45° field of view — 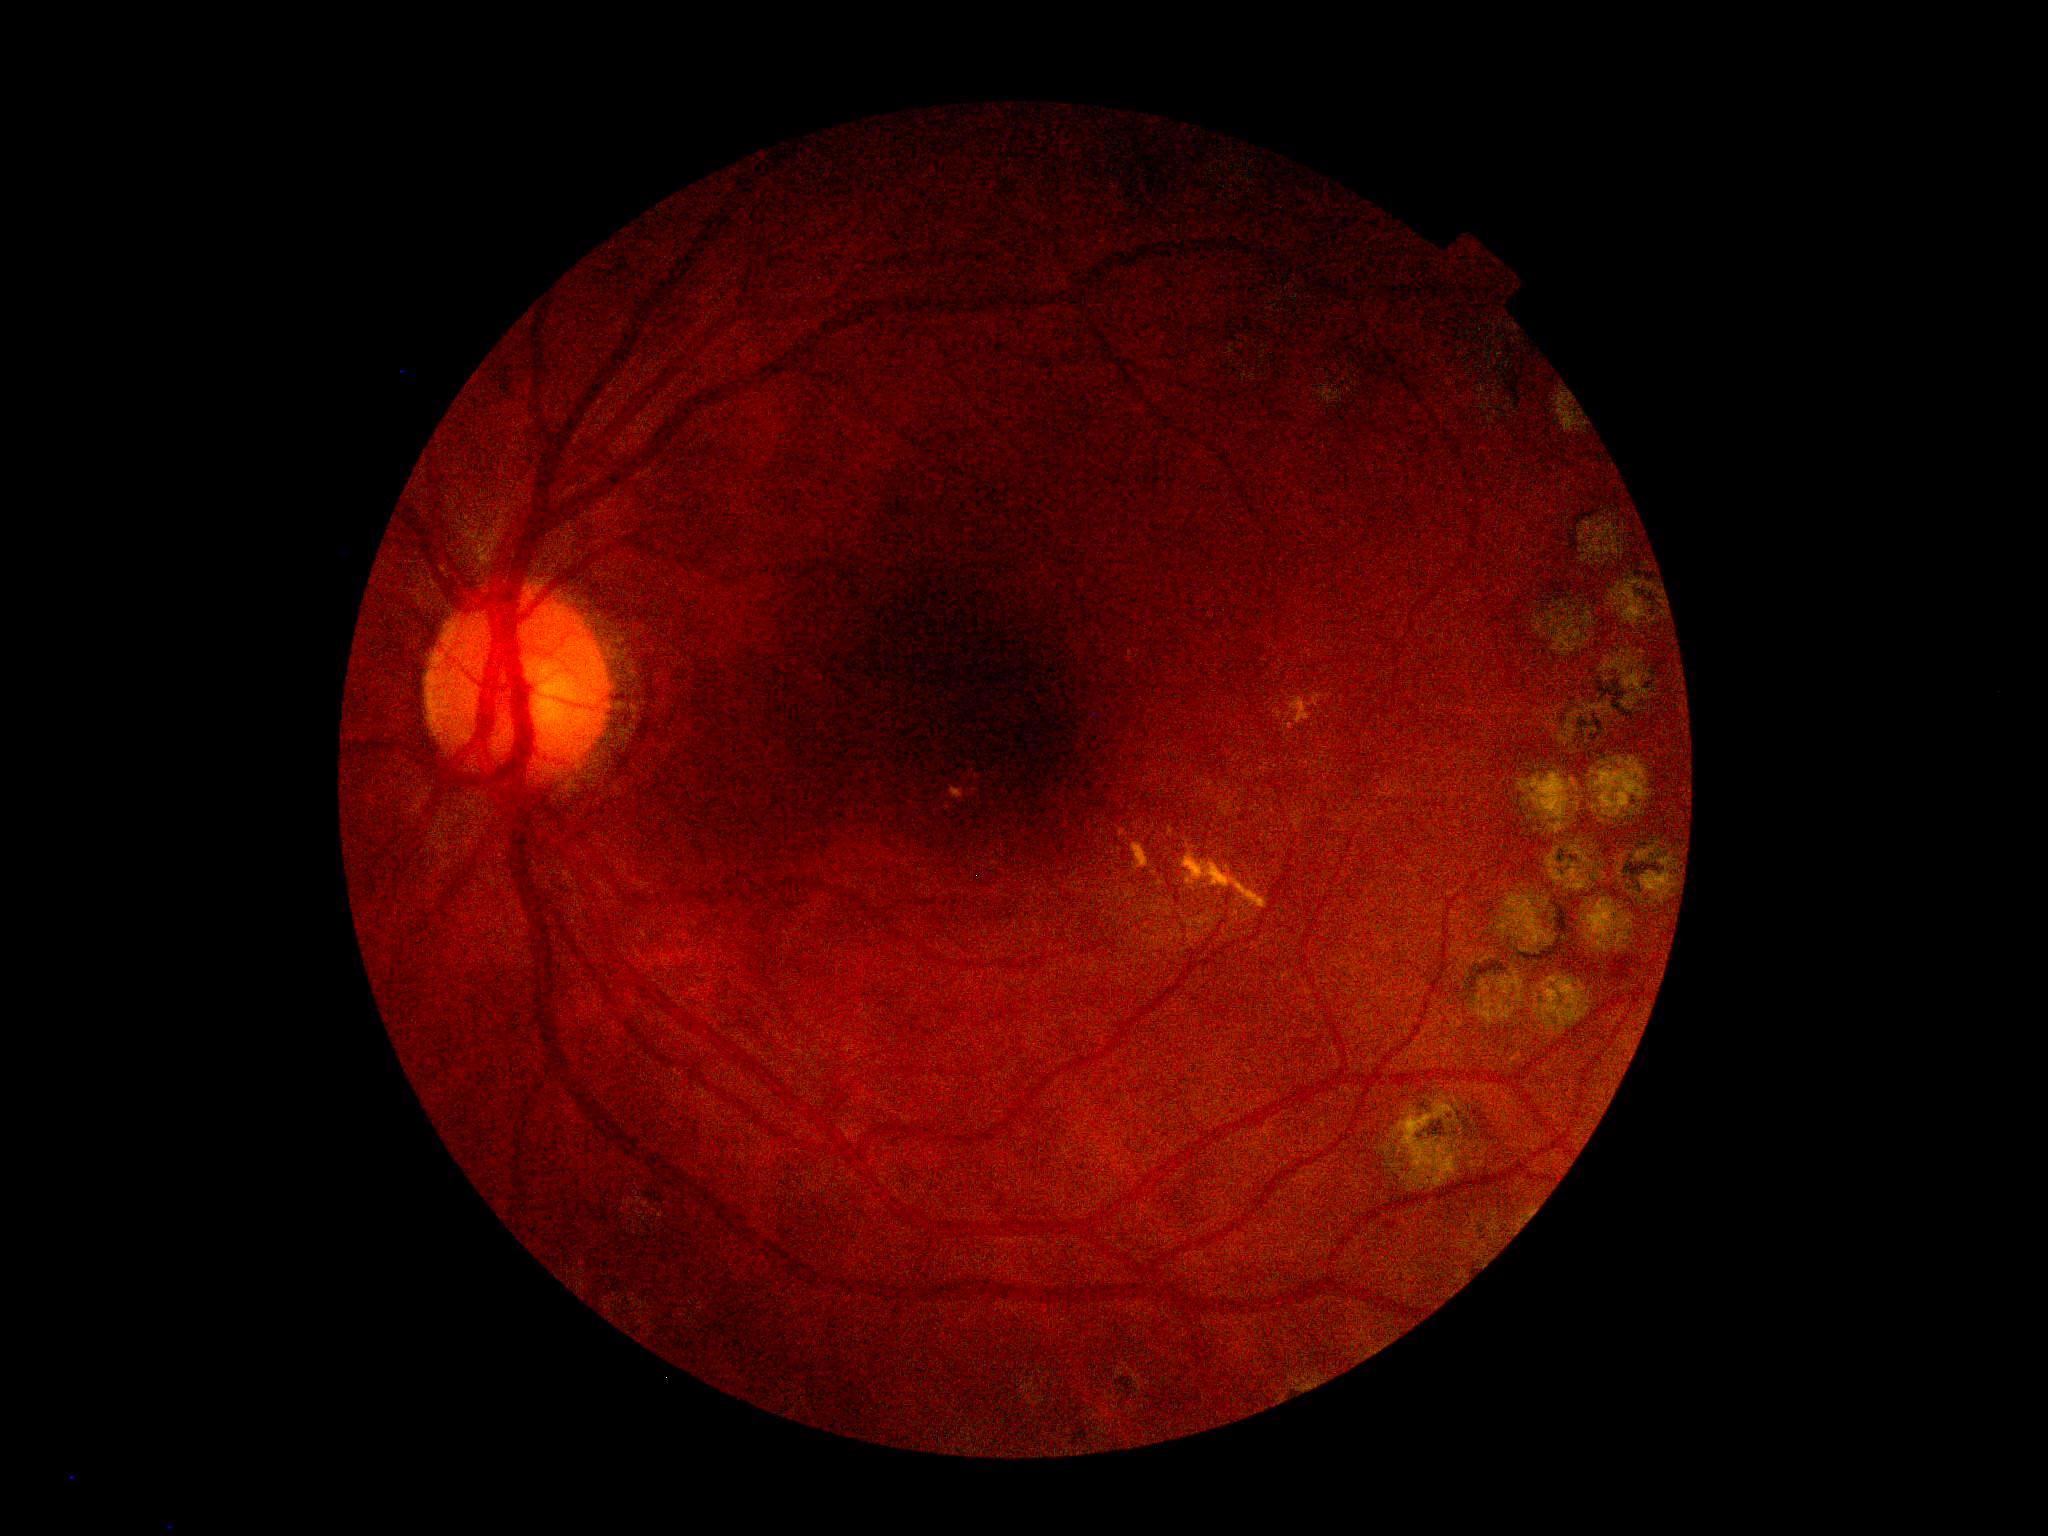 DR stage: grade 2 (moderate NPDR).